Wide-field fundus image from infant ROP screening.
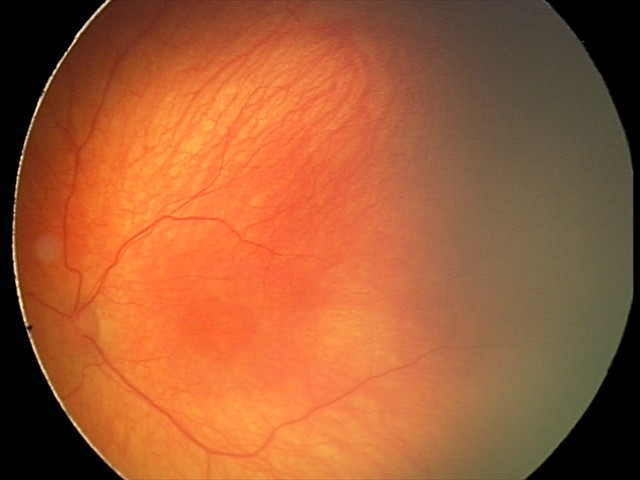
Examination with physiological retinal findings.